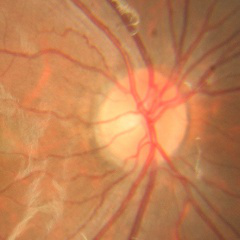 Optic nerve head appearance consistent with no evidence of glaucoma.